2352x1568 · CFP · 45° FOV: 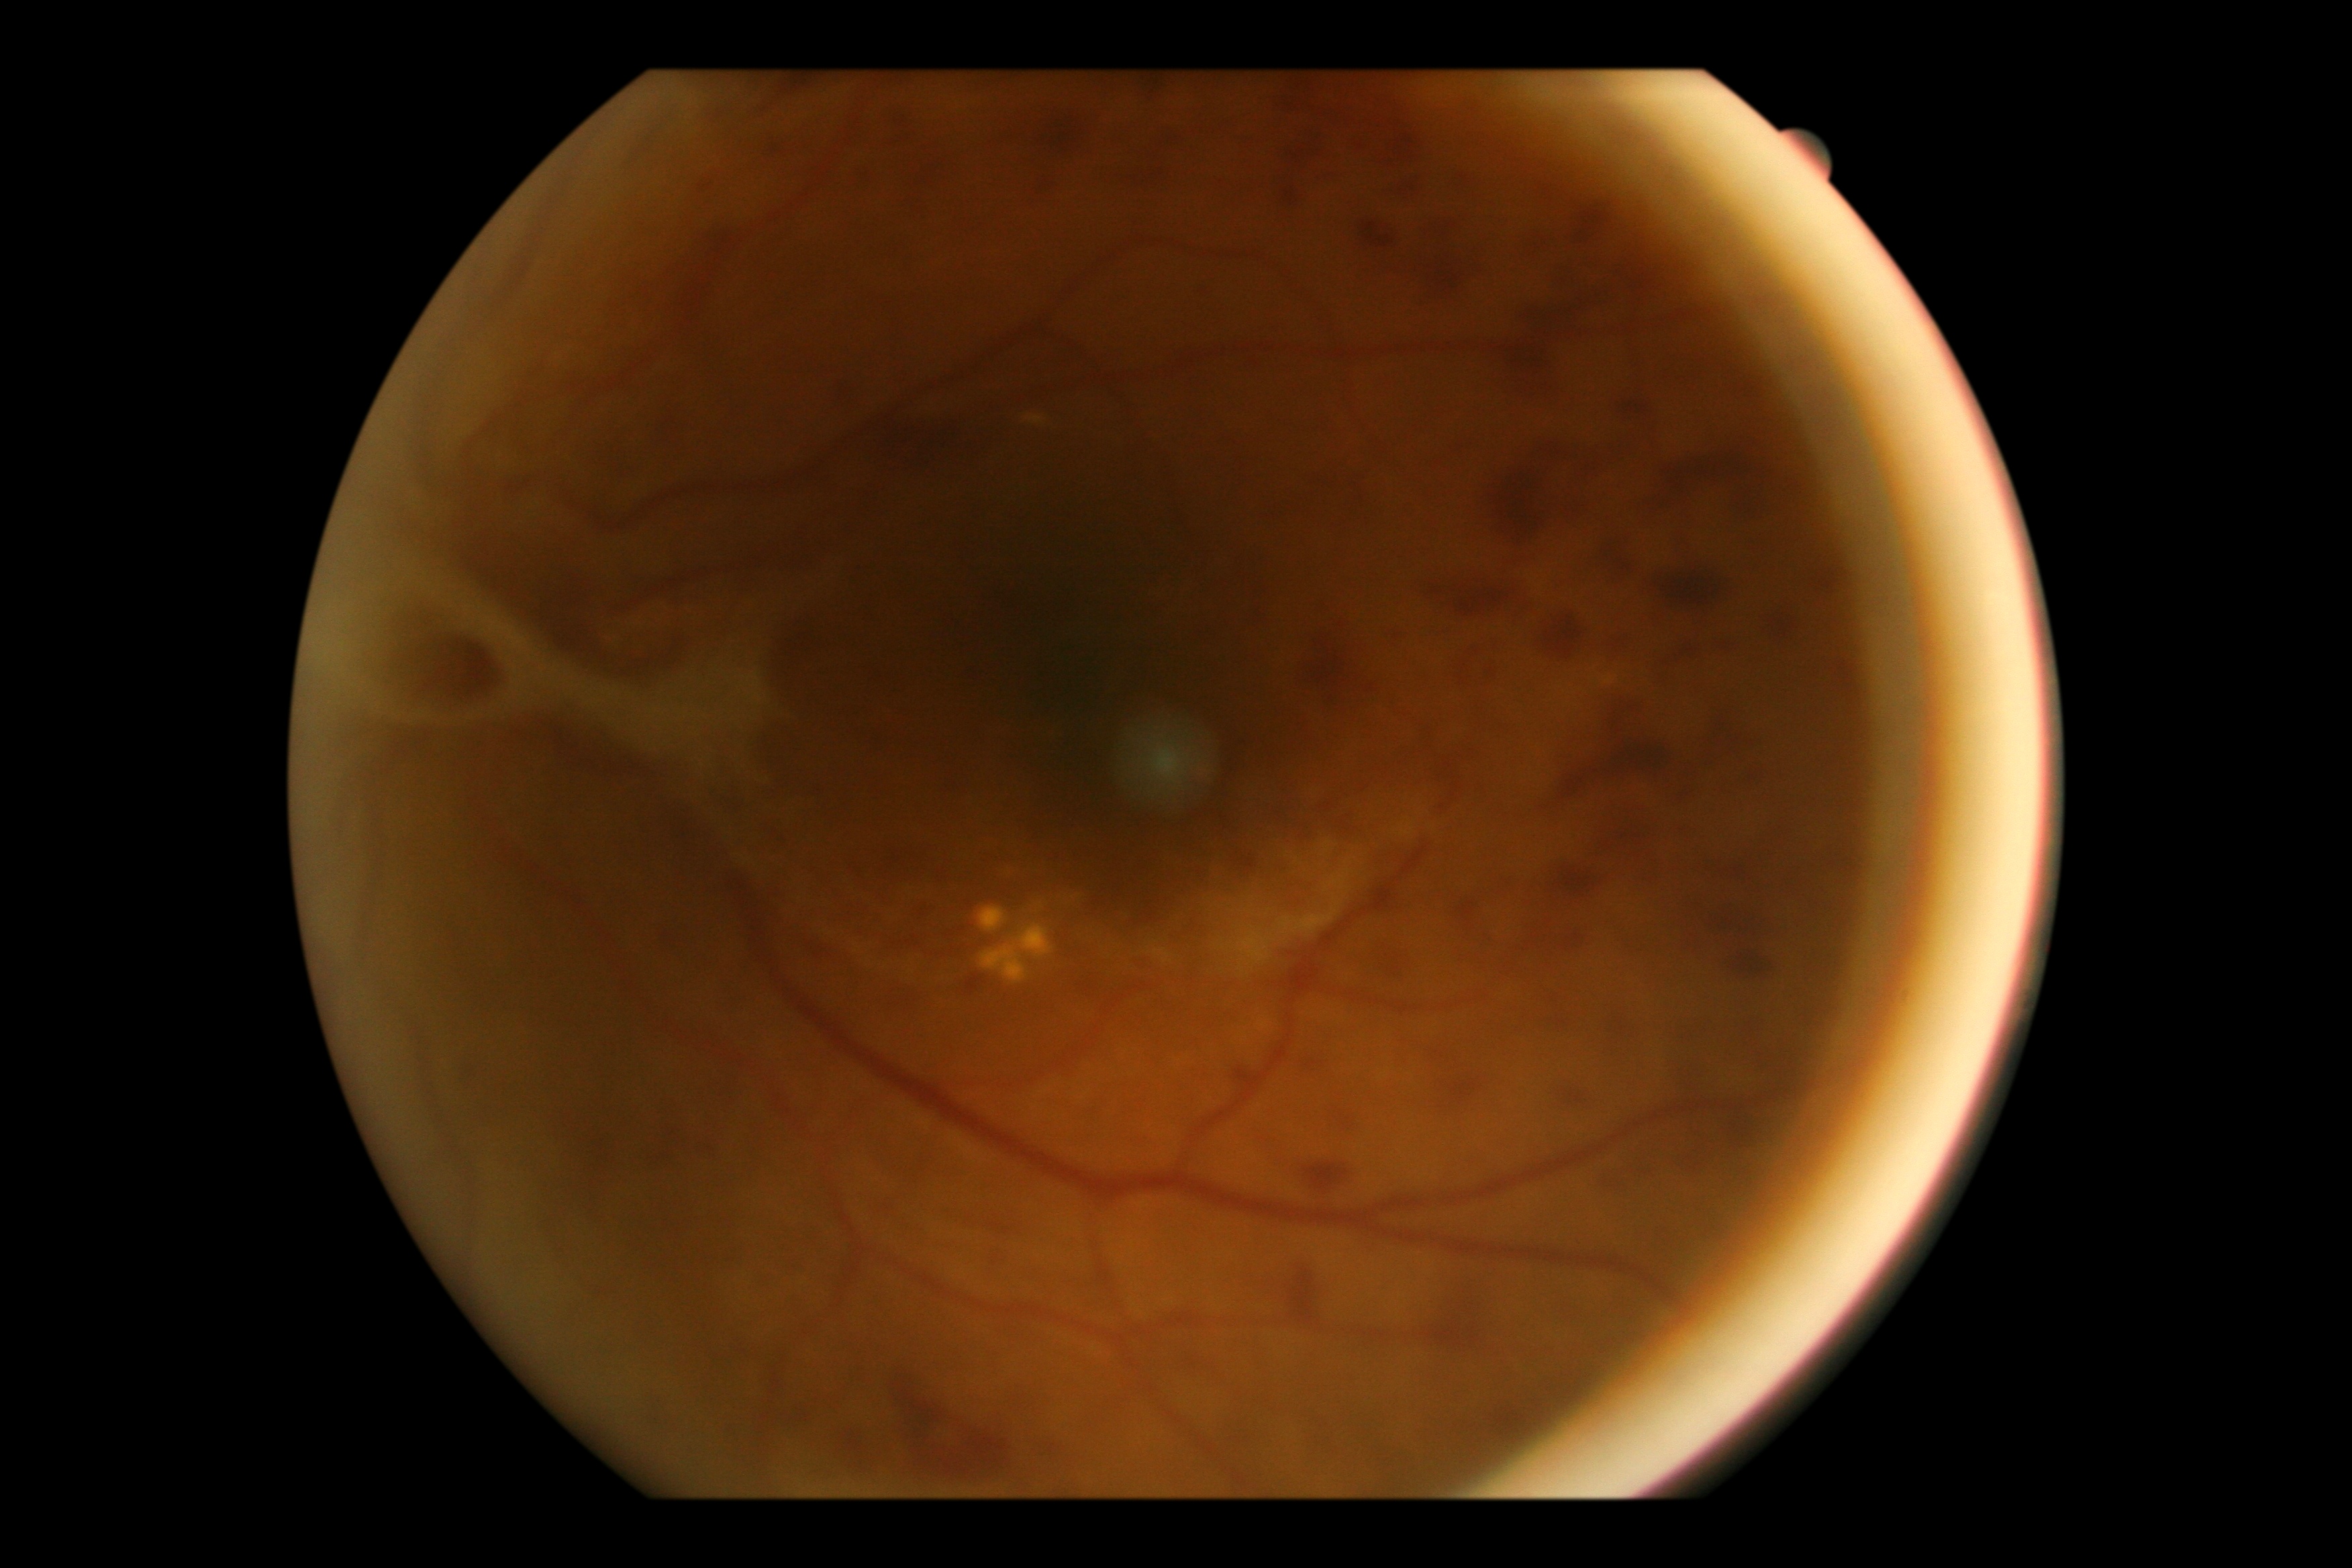 DR grade is PDR (4). Disease class: proliferative diabetic retinopathy.